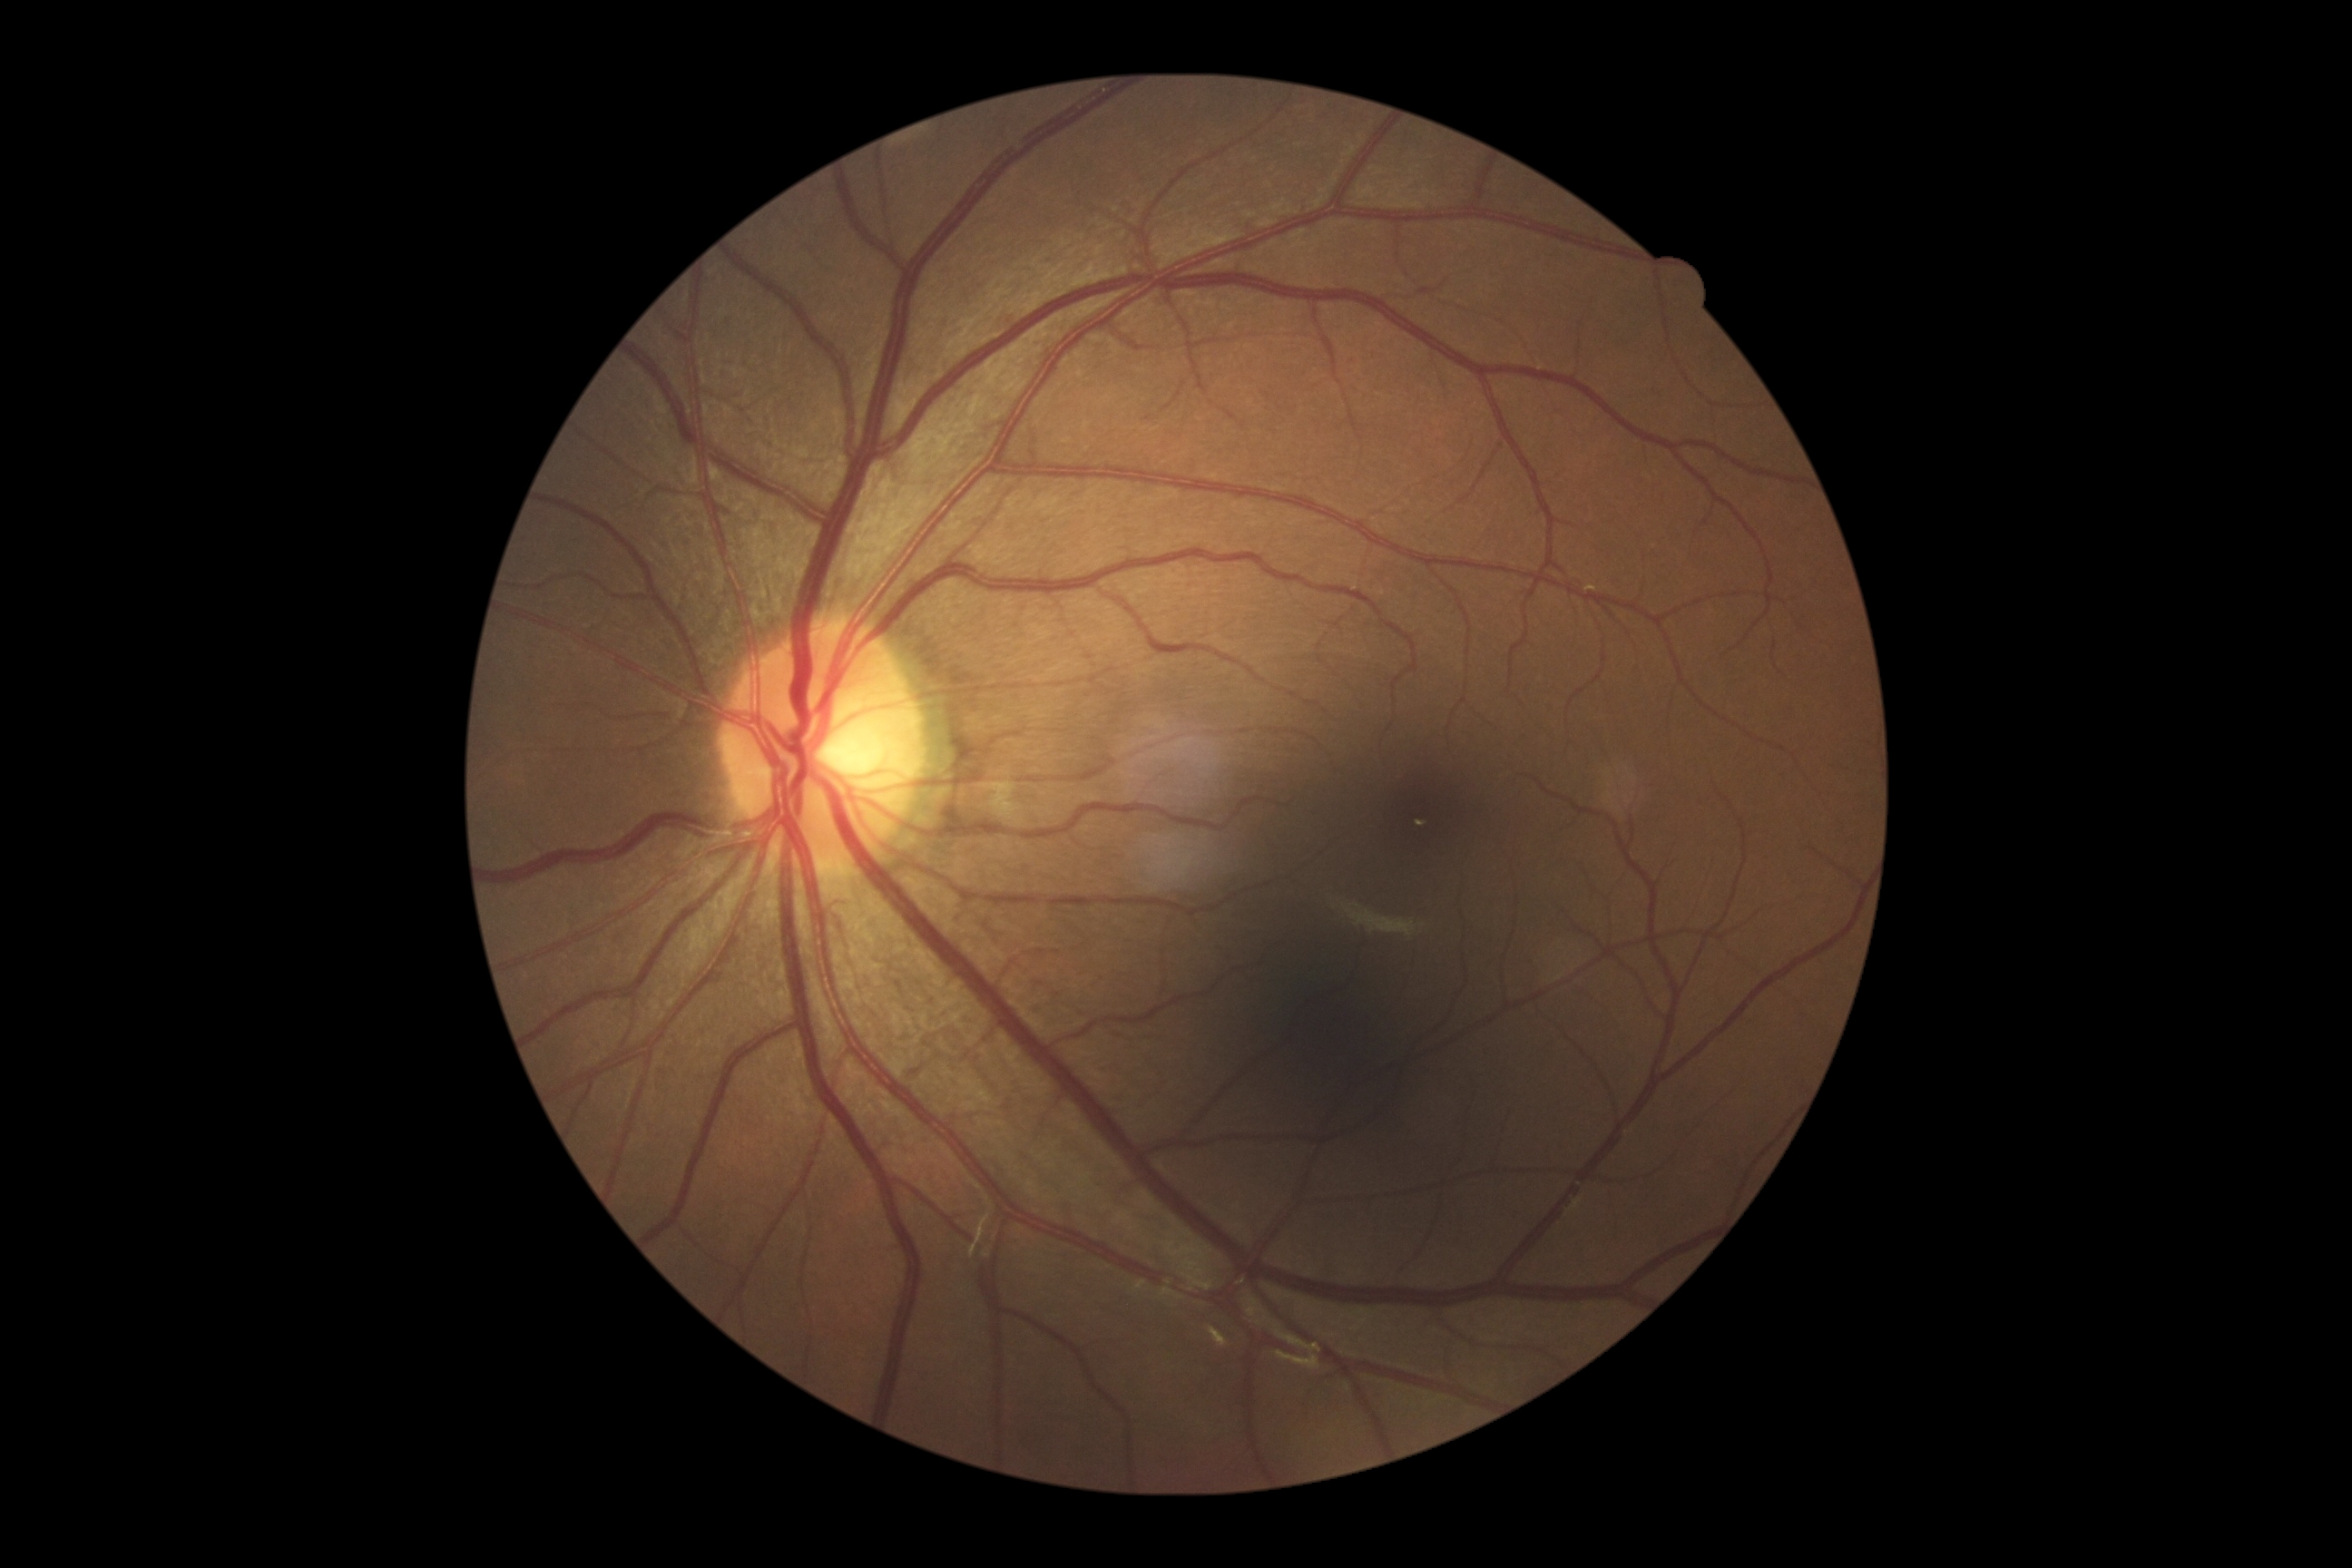
DR impression=no DR findings; DR=0.